Without pupil dilation, posterior pole color fundus photograph
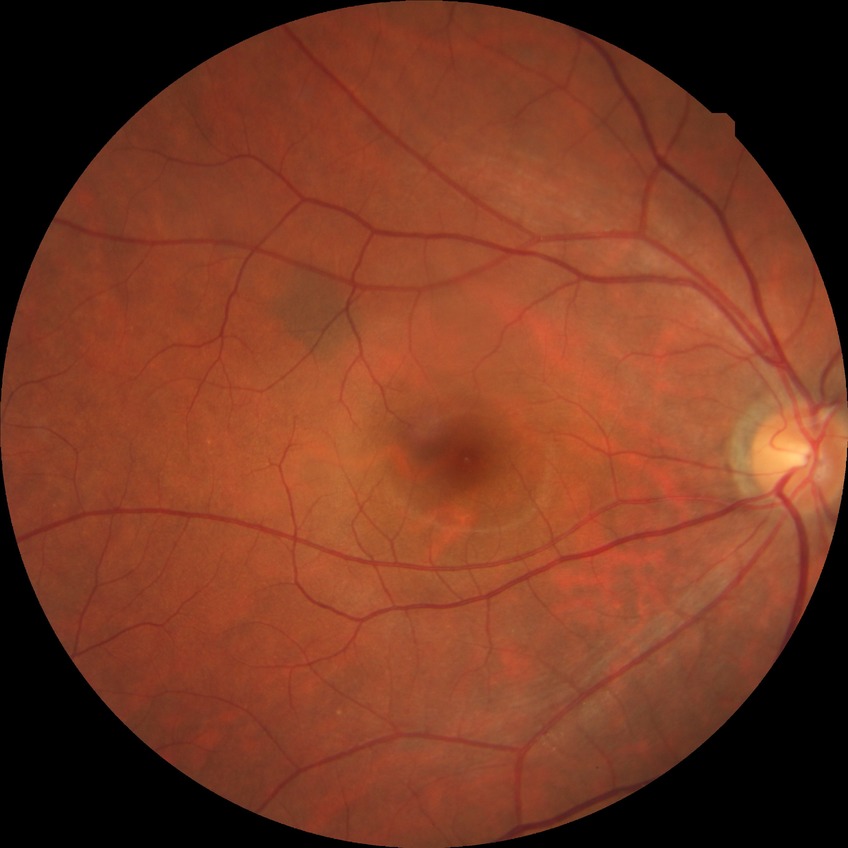

DR stage: NDR.